848 by 848 pixels. Acquired with a NIDEK AFC-230. Davis DR grading
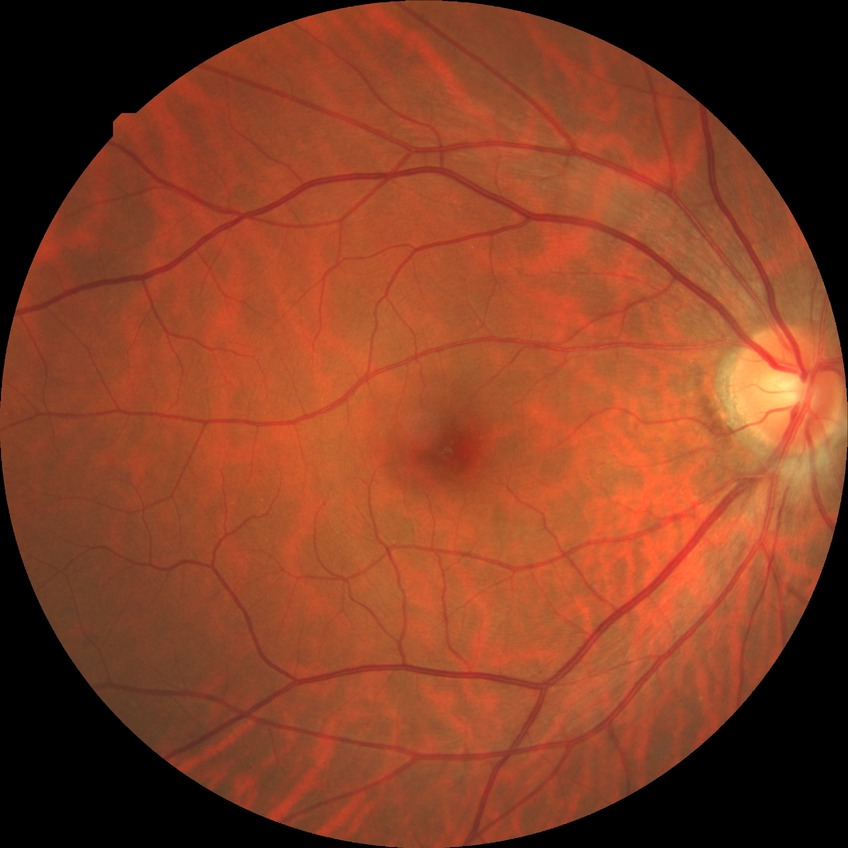 diabetic retinopathy (DR) = no diabetic retinopathy (NDR).